FOV: 45 degrees — 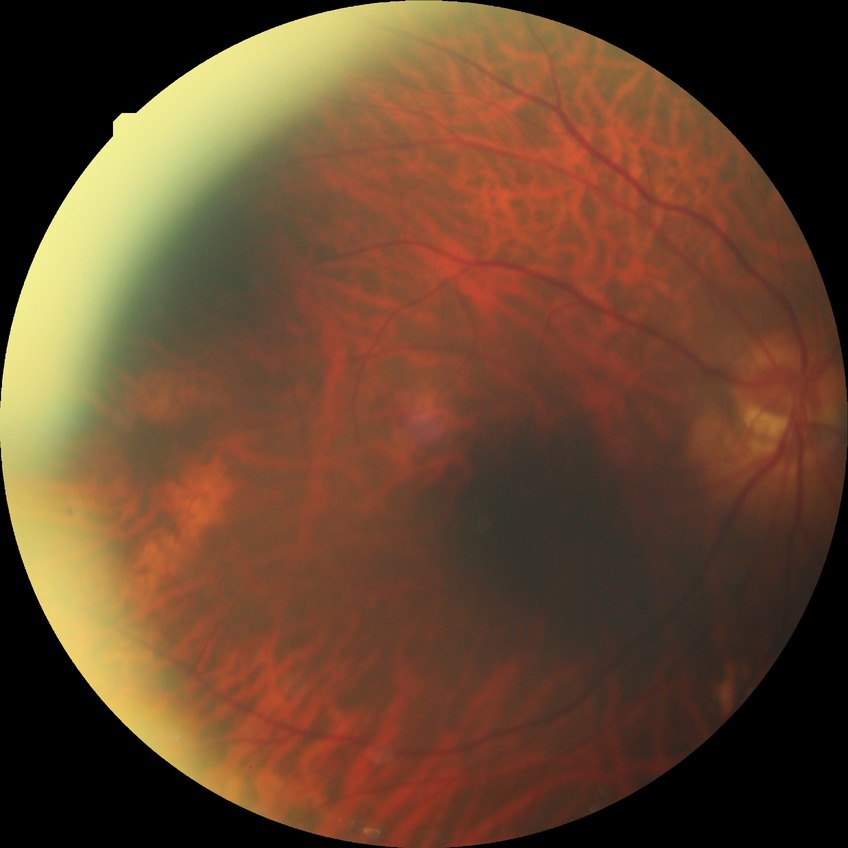 Diabetic retinopathy severity: no diabetic retinopathy.